FOV: 45 degrees; modified Davis grading — 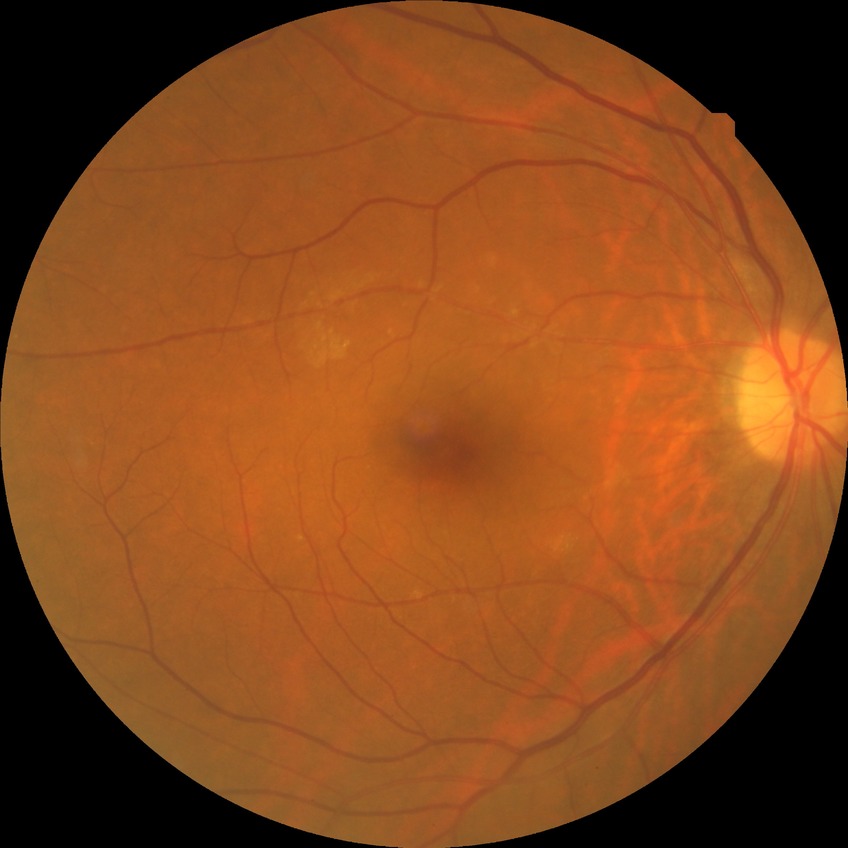

  davis_grade: no diabetic retinopathy (NDR)